2048 x 1536 pixels; FOV: 45 degrees:
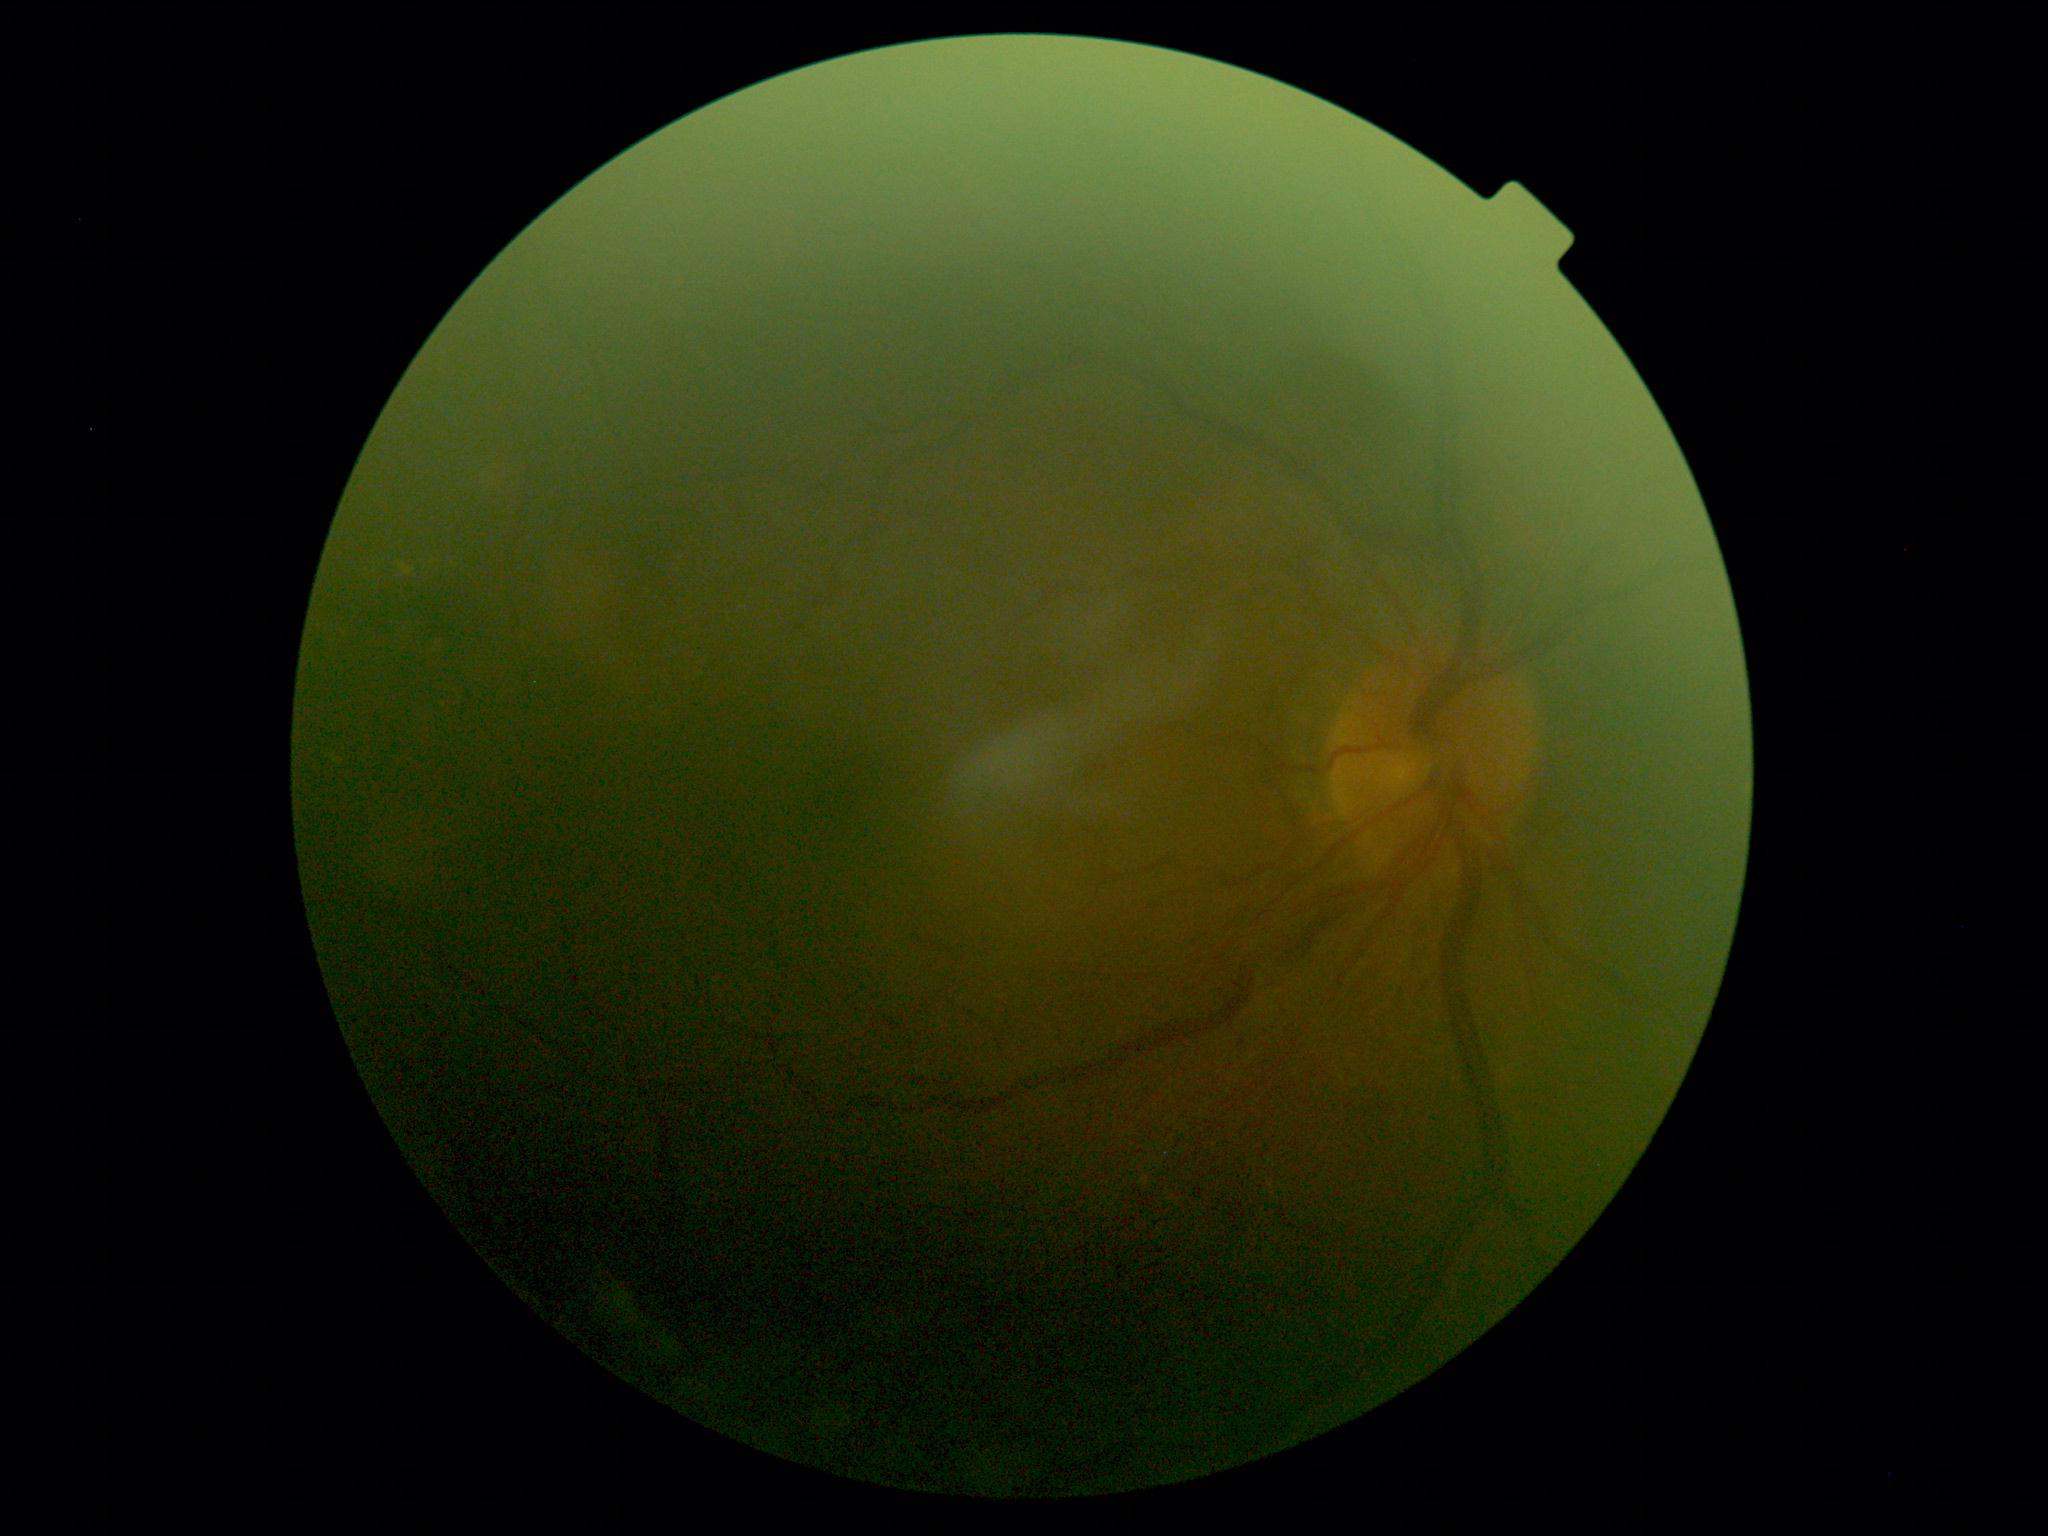 DR is moderate non-proliferative diabetic retinopathy (grade 2).